CFP; 2352 x 1568 pixels: 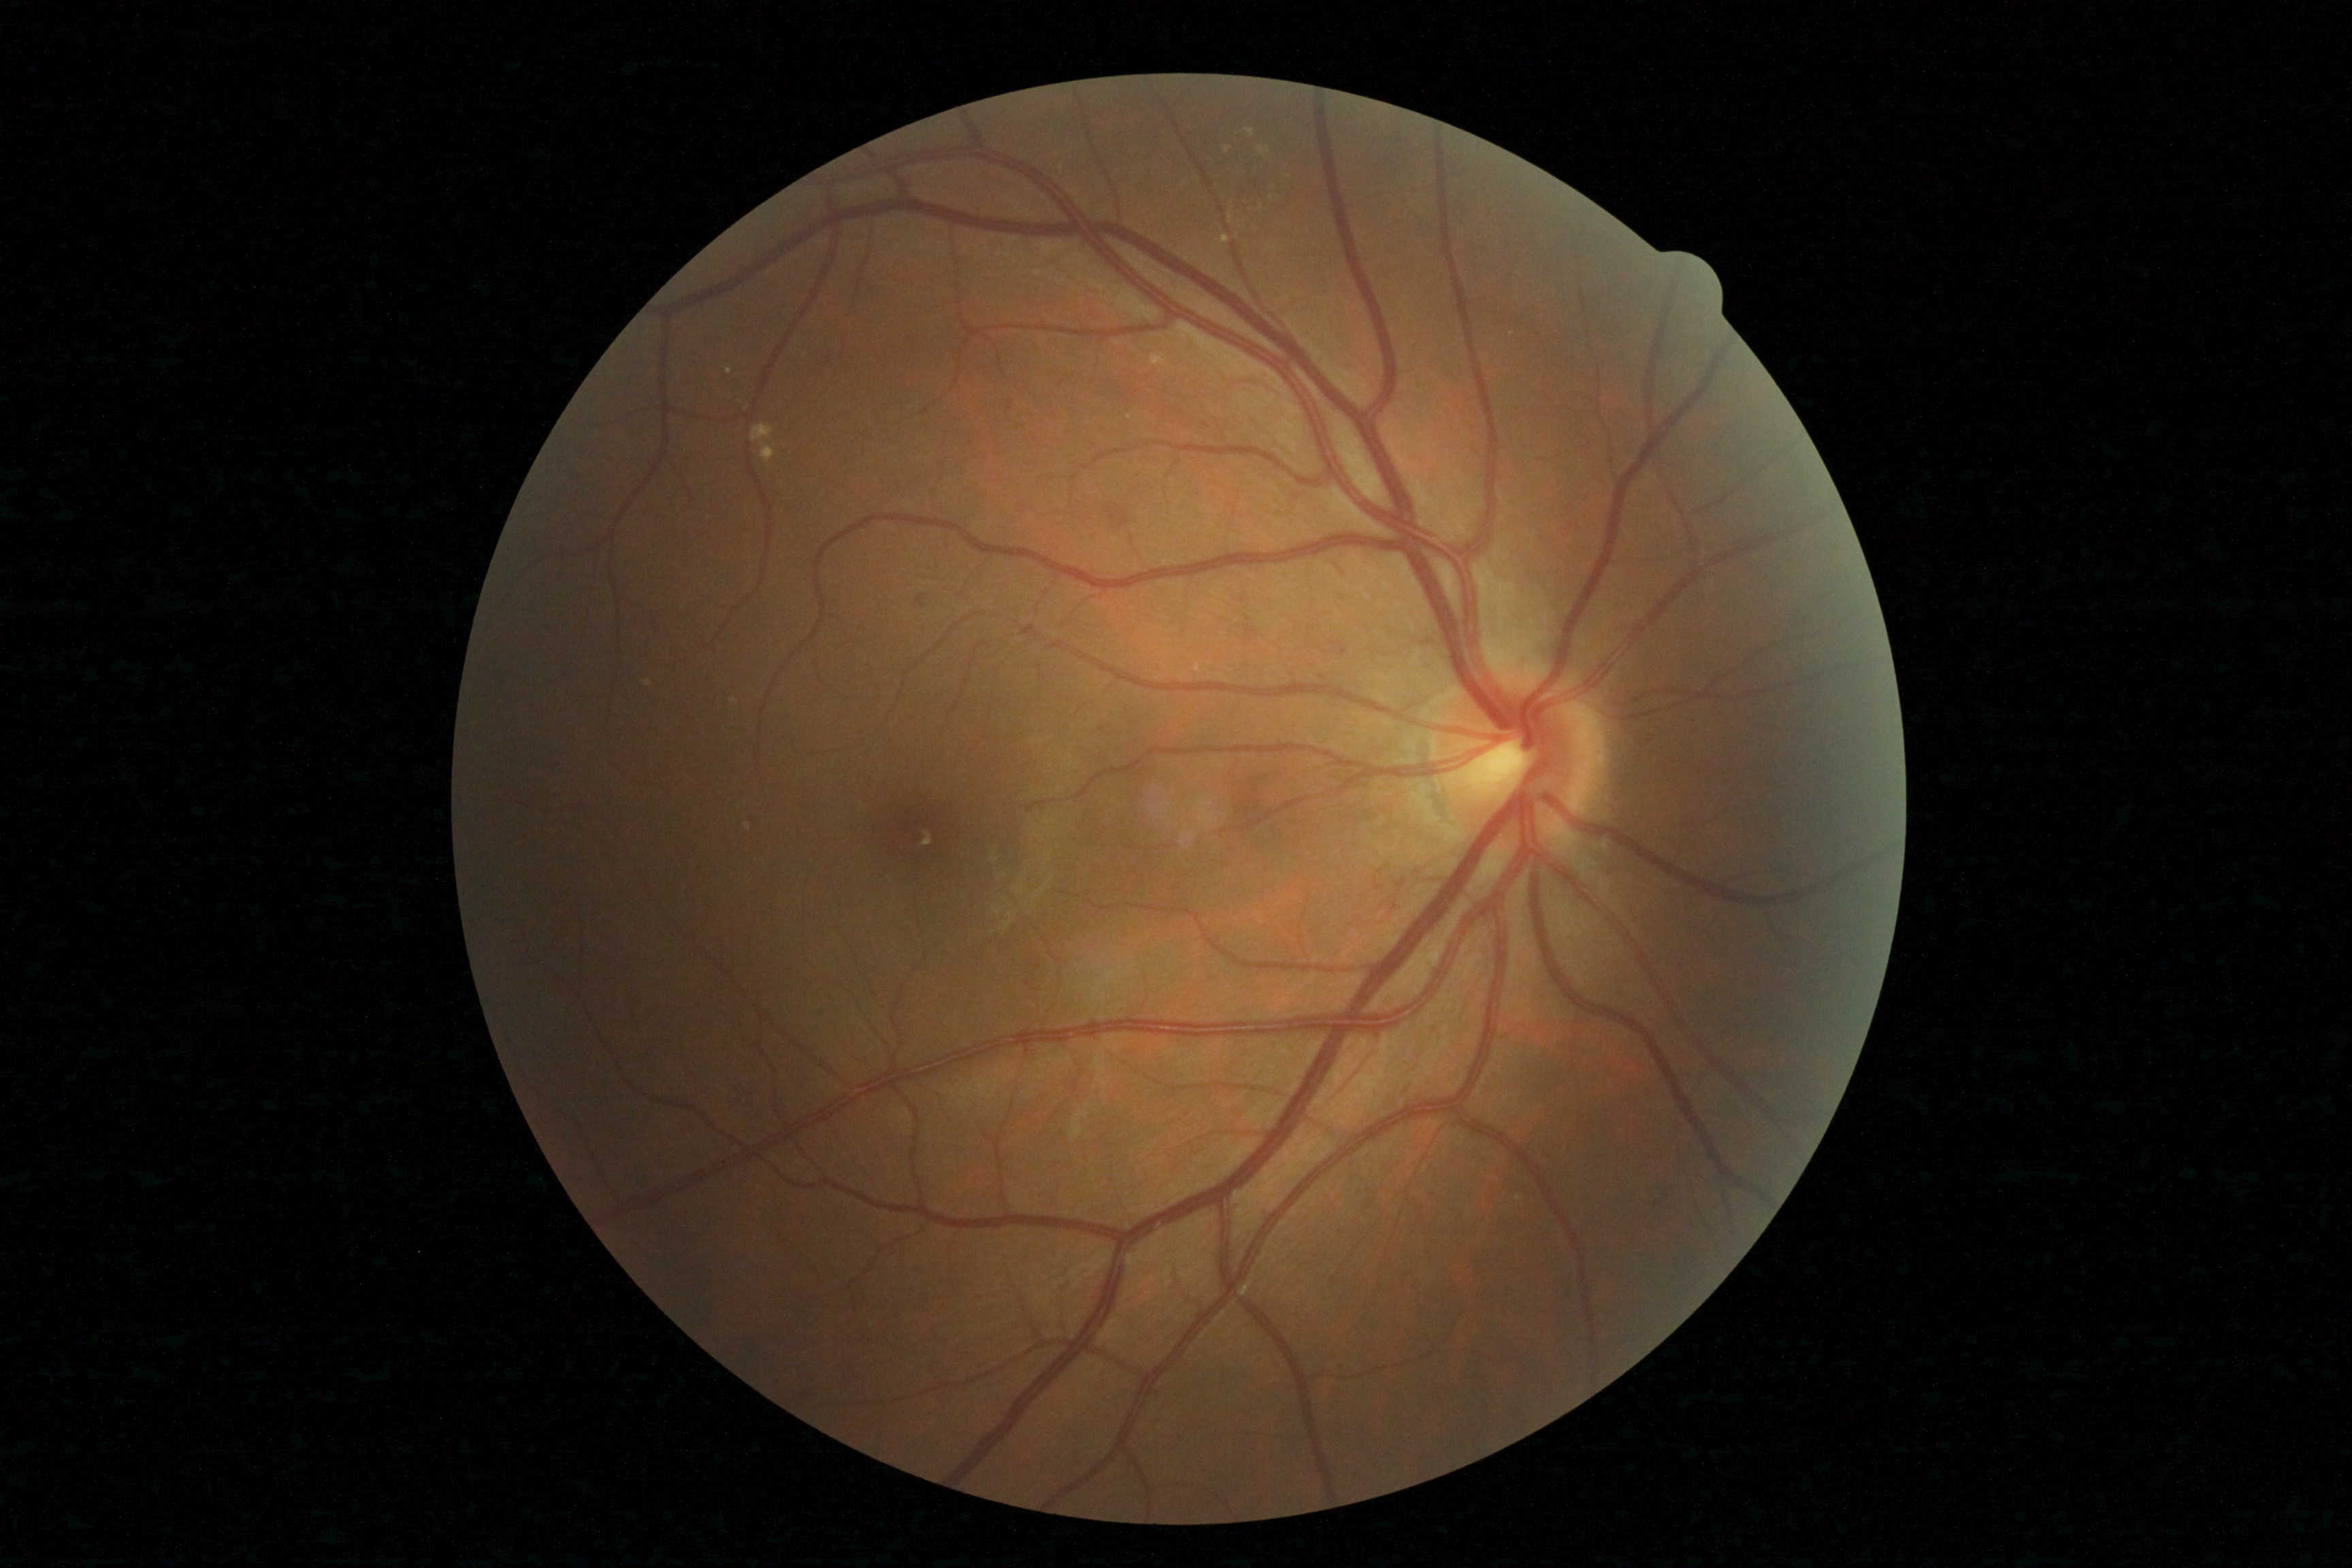 Diabetic retinopathy severity: 2/4.